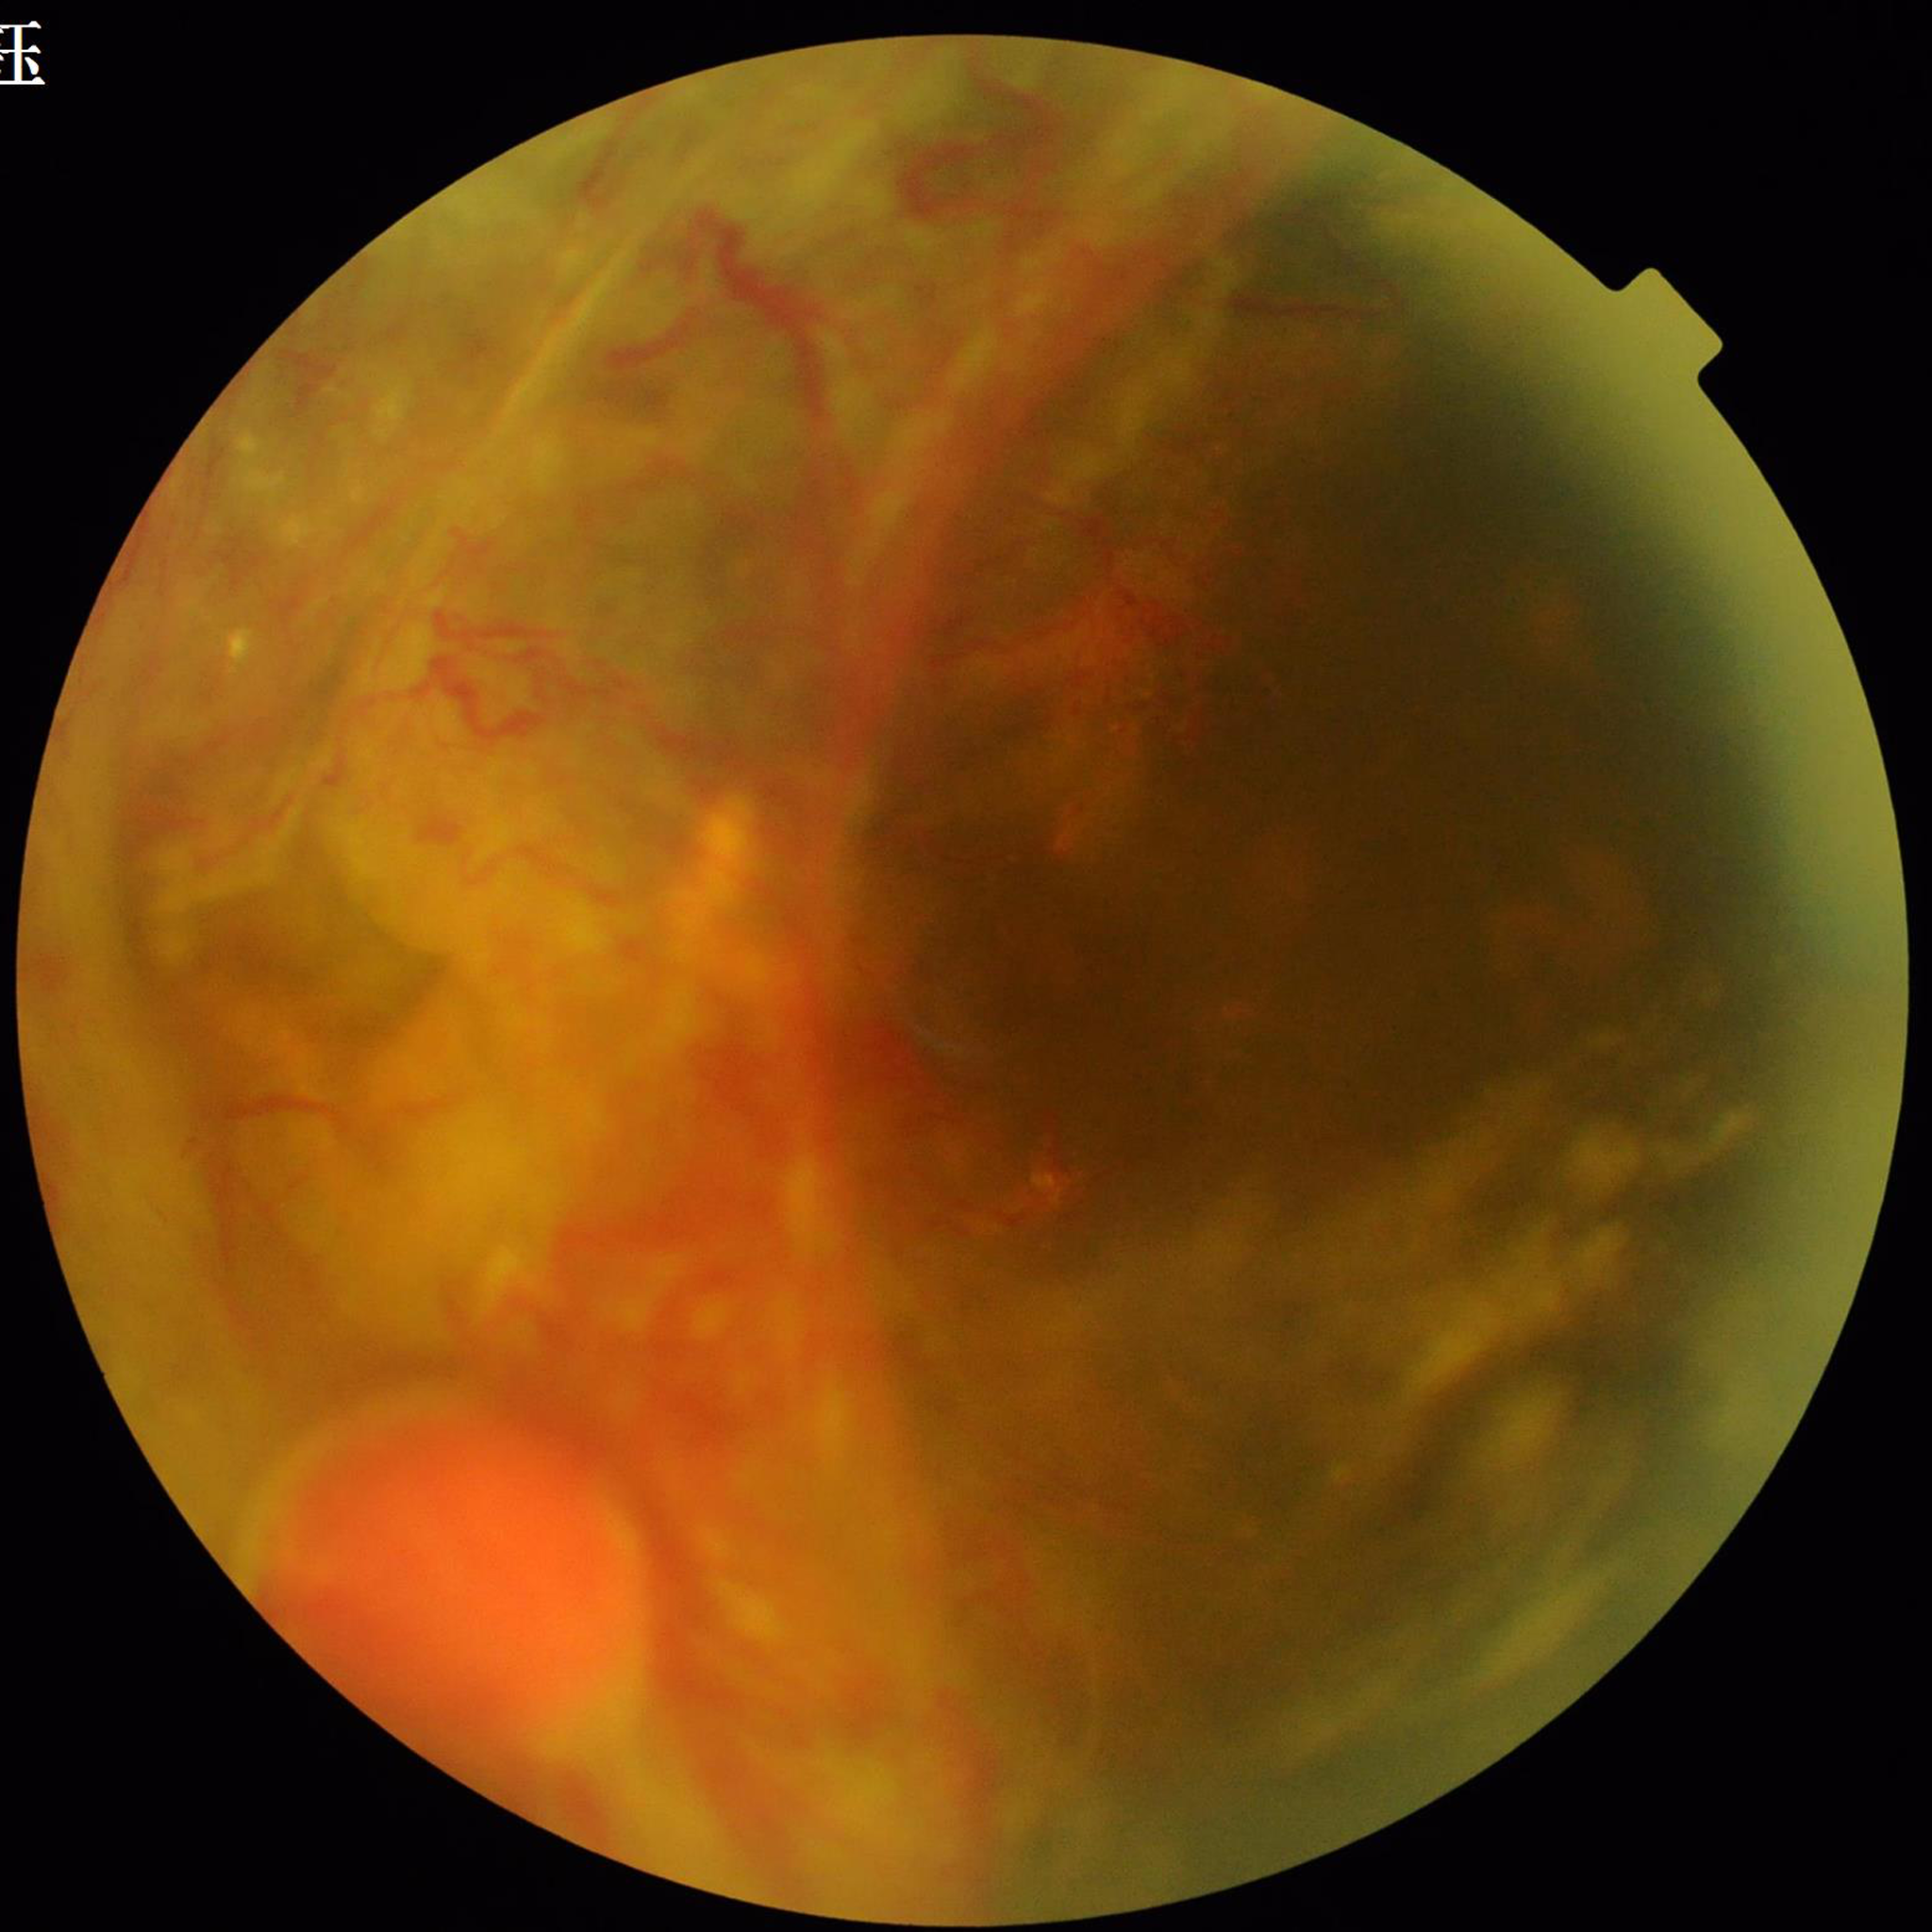
{
  "diagnosis": "diabetic retinopathy"
}